Optic nerve head photograph. Captured with pupil dilation. Image size 658x658: 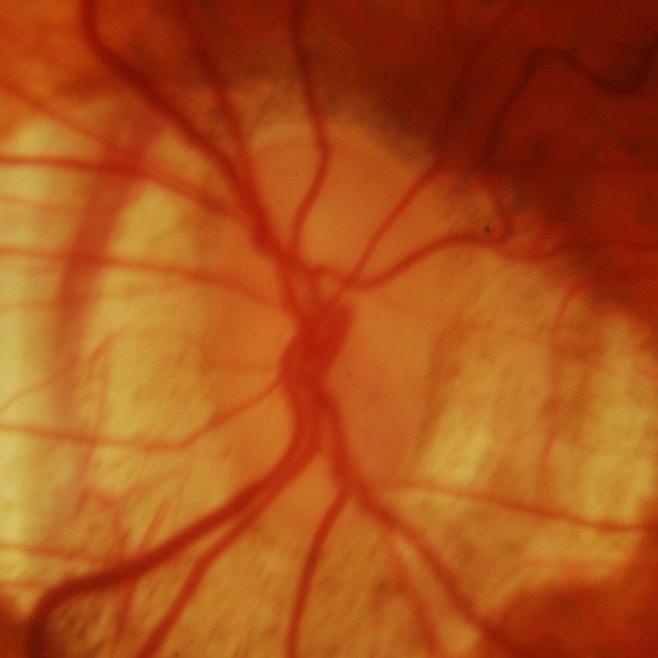

Glaucoma is present. Consistent with evidence of glaucoma.